1240x1240. Wide-field contact fundus photograph of an infant
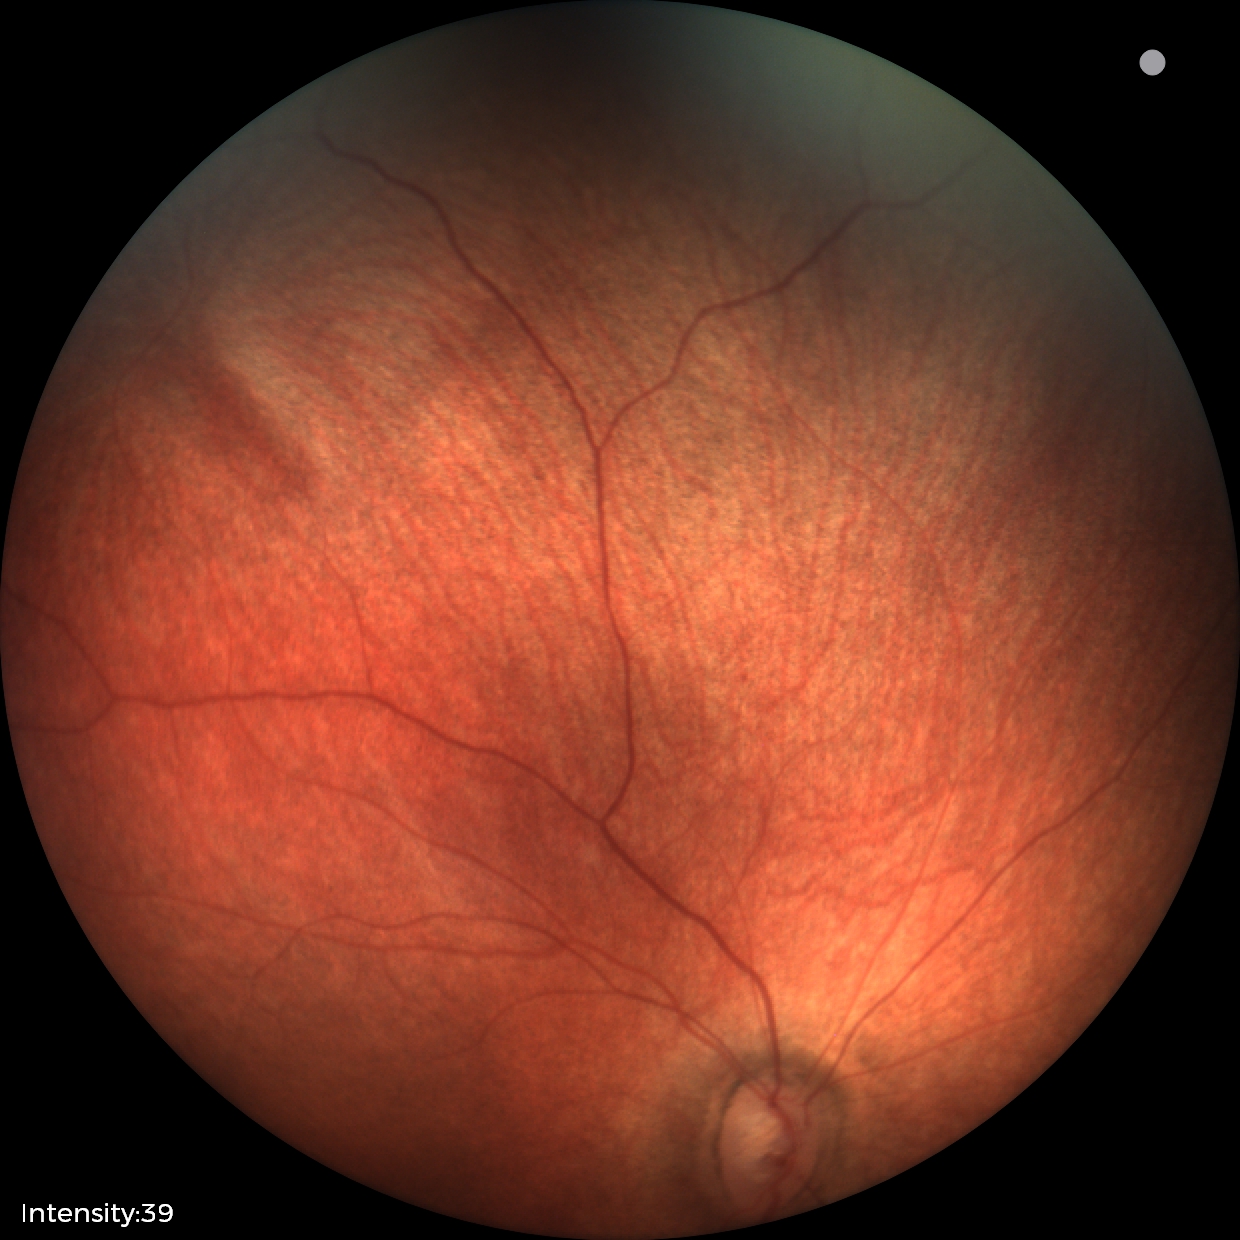

Physiological retinal appearance for postconceptual age.